45° FOV: 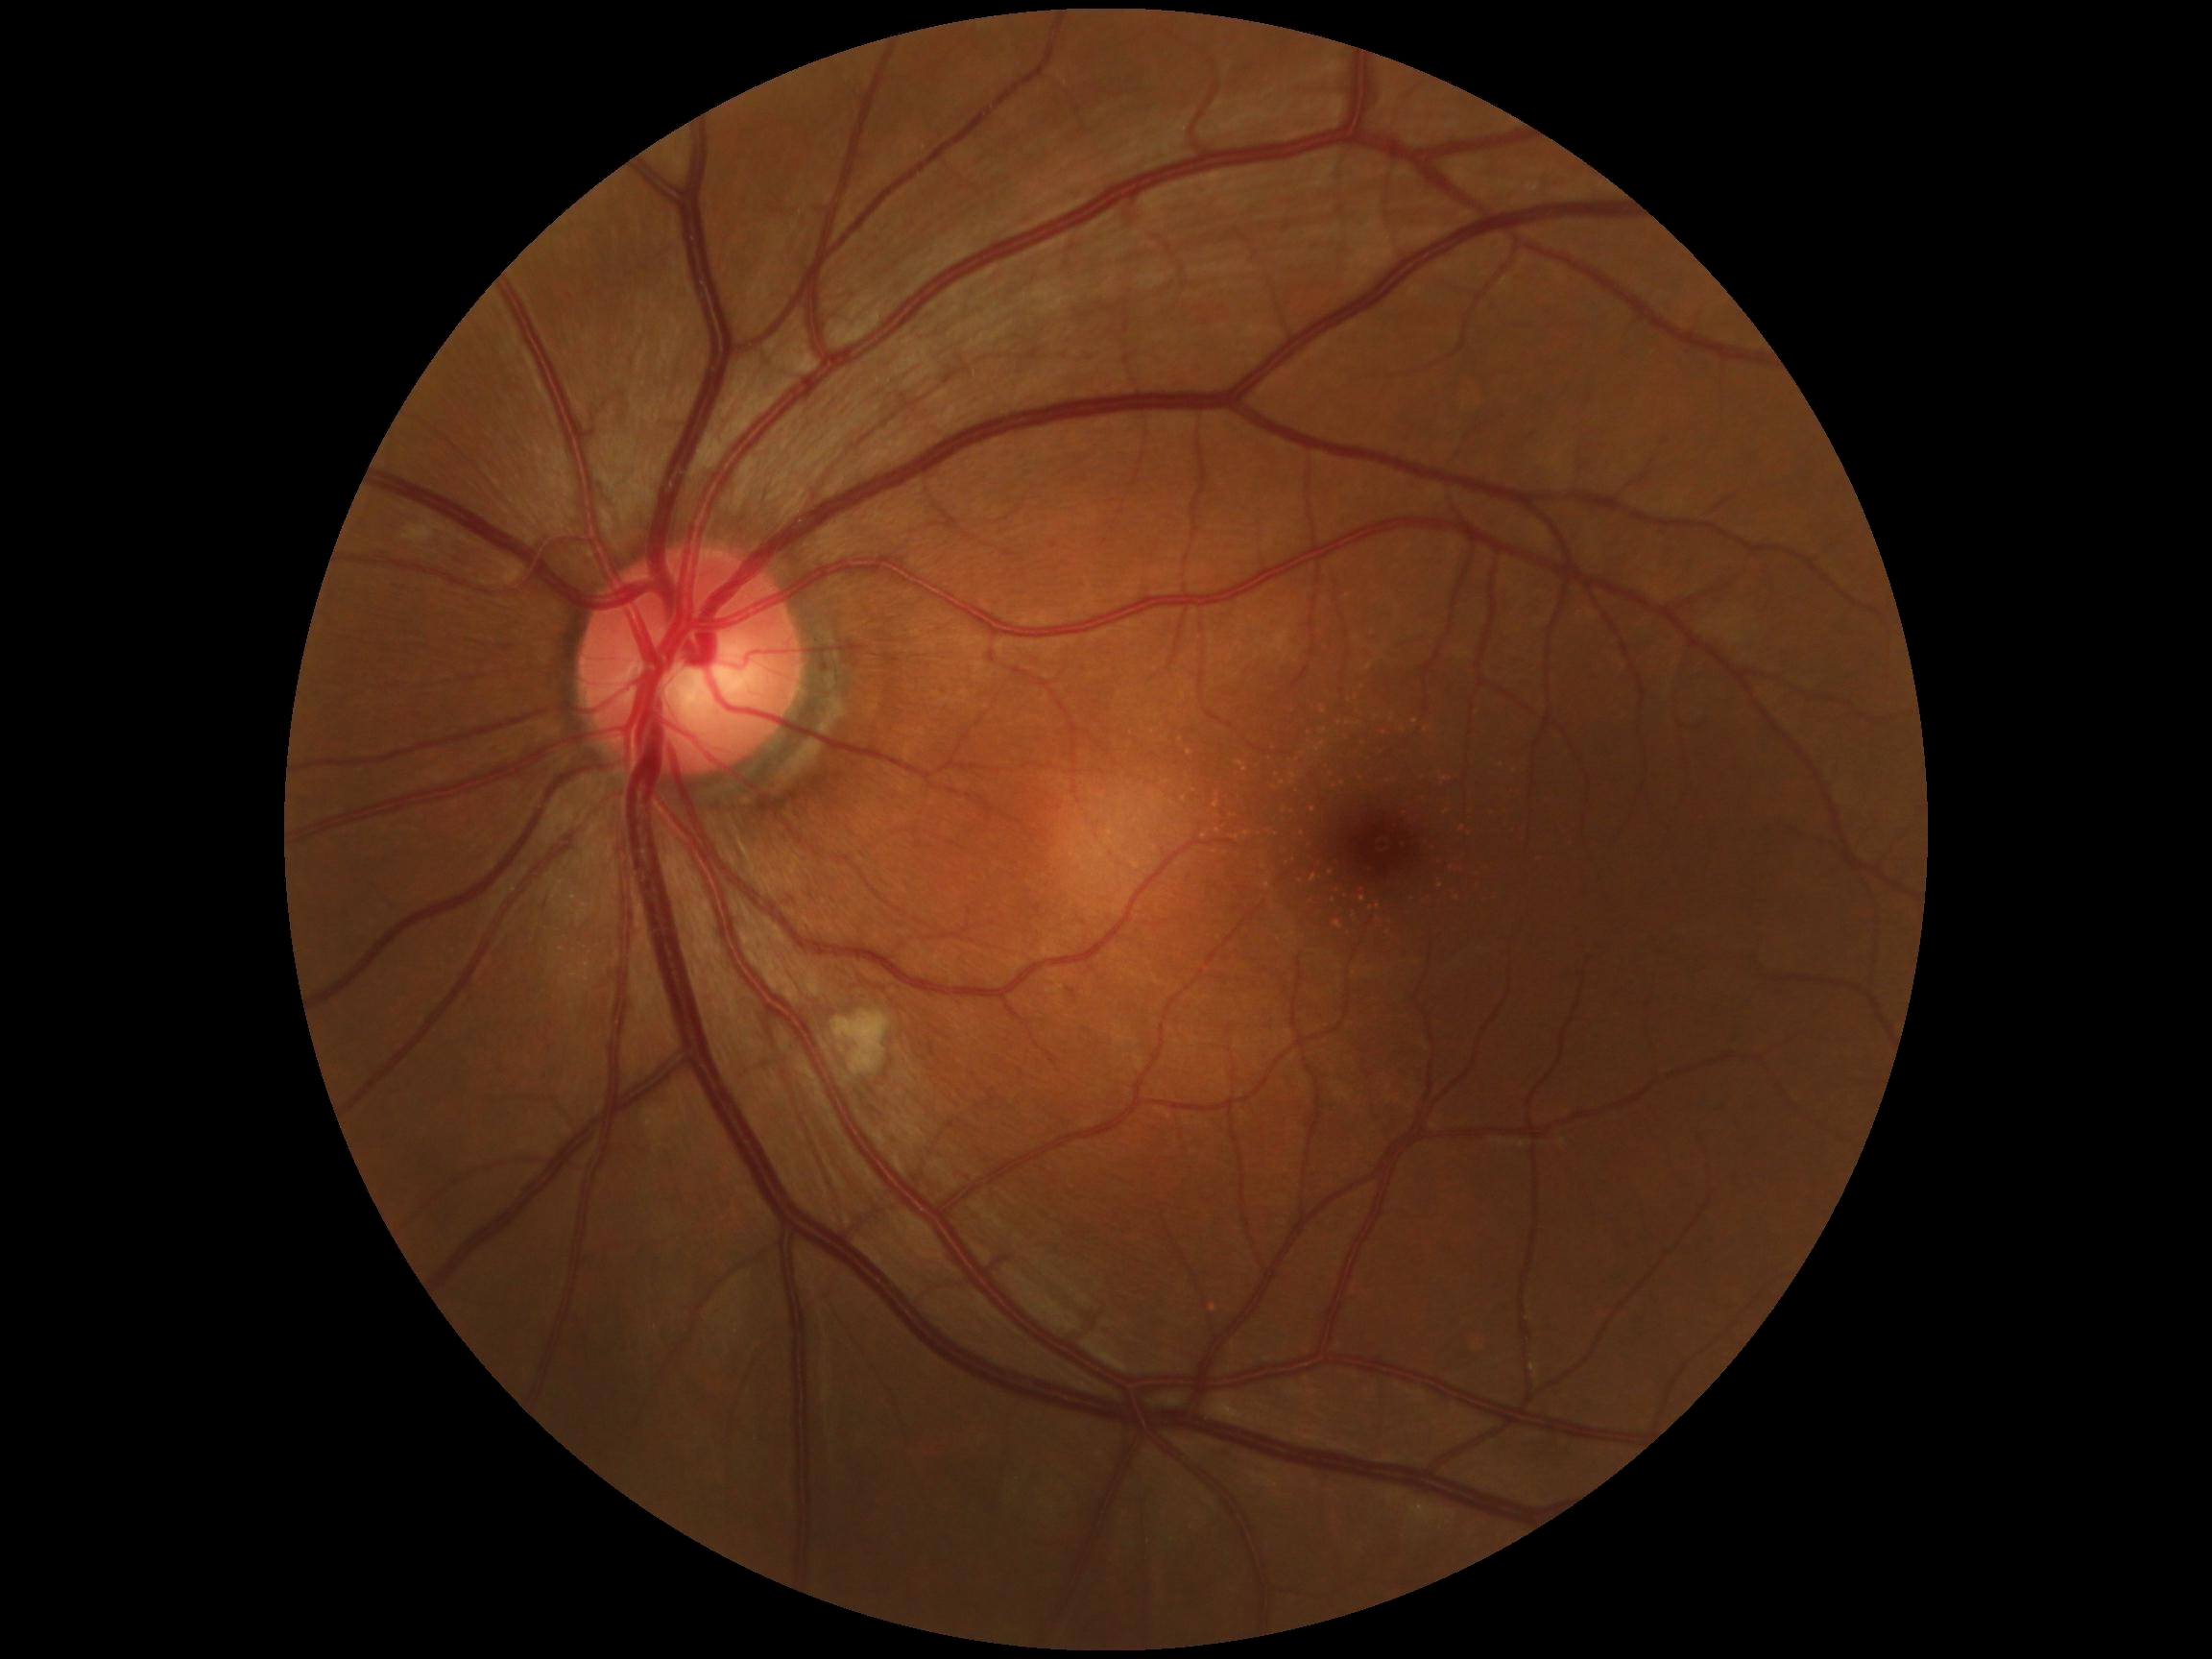
dr_grade: 2/4 — more than just microaneurysms but less than severe NPDR